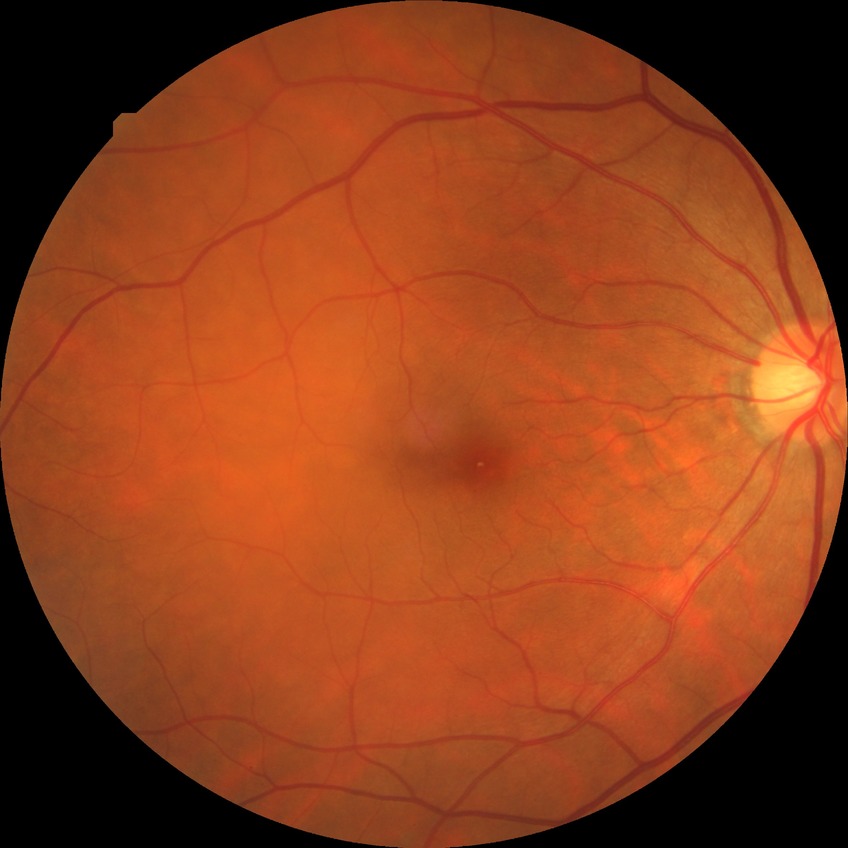
Findings:
* diabetic retinopathy (DR): no diabetic retinopathy (NDR)